Wide-field contact fundus photograph of an infant · Phoenix ICON, 100° FOV · 1240x1240px: 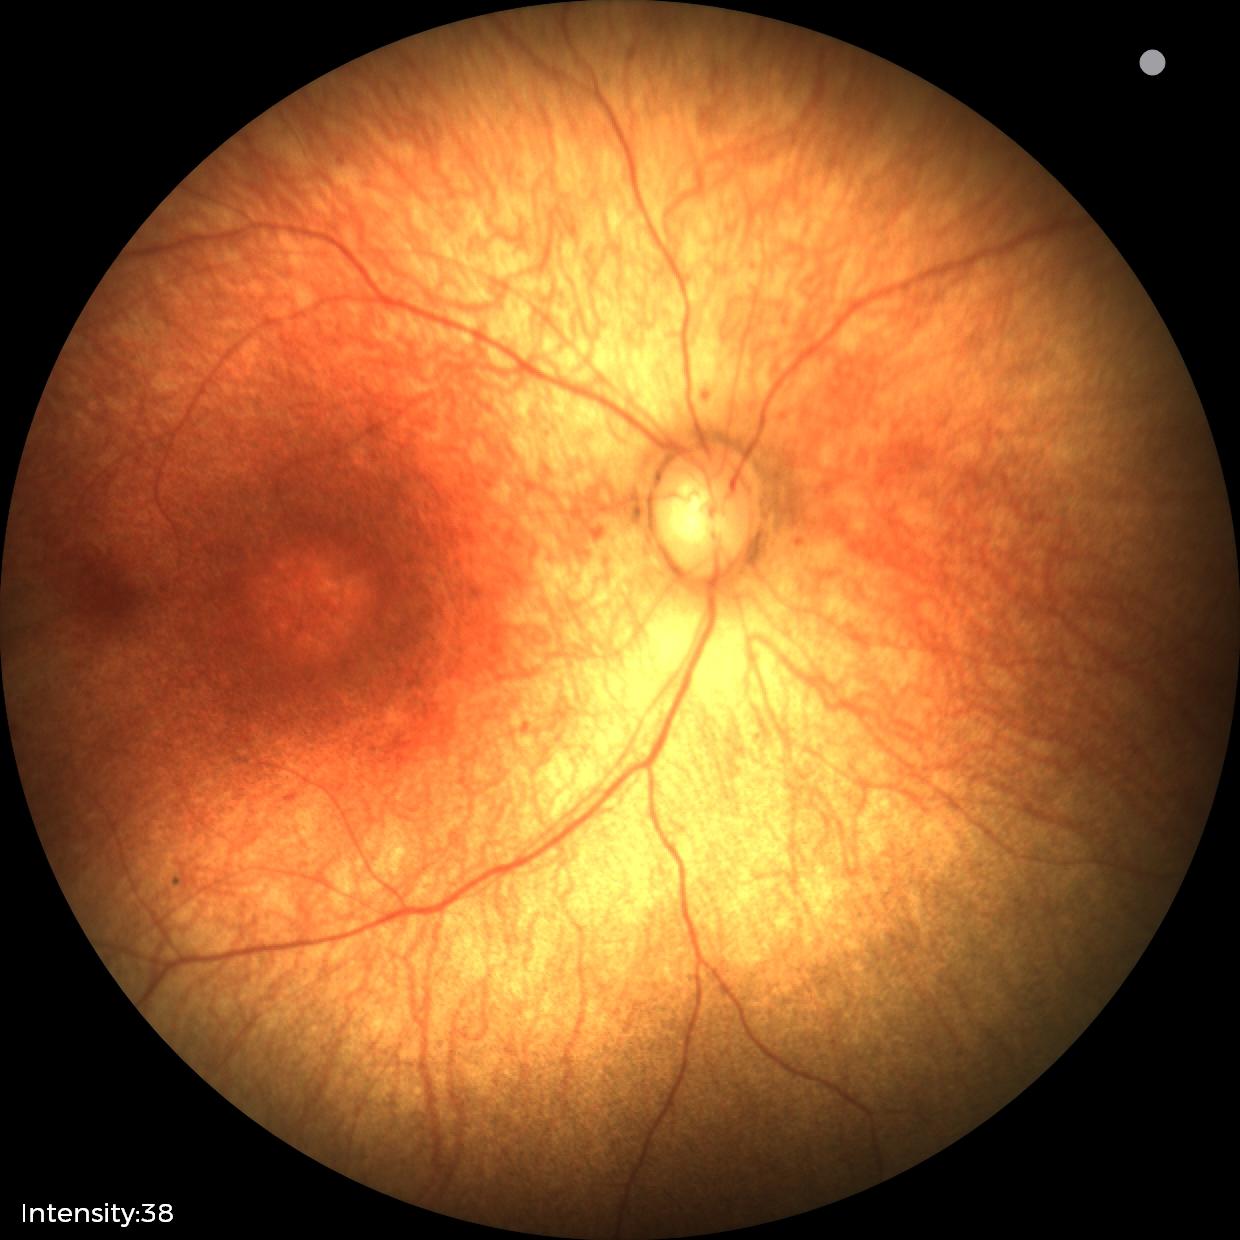

Examination with physiological retinal findings.